240x240, disc-centered field
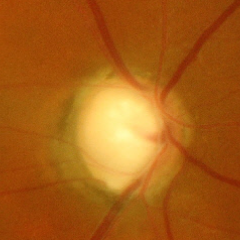
Fundus appearance consistent with advanced glaucomatous optic neuropathy.